45-degree field of view — 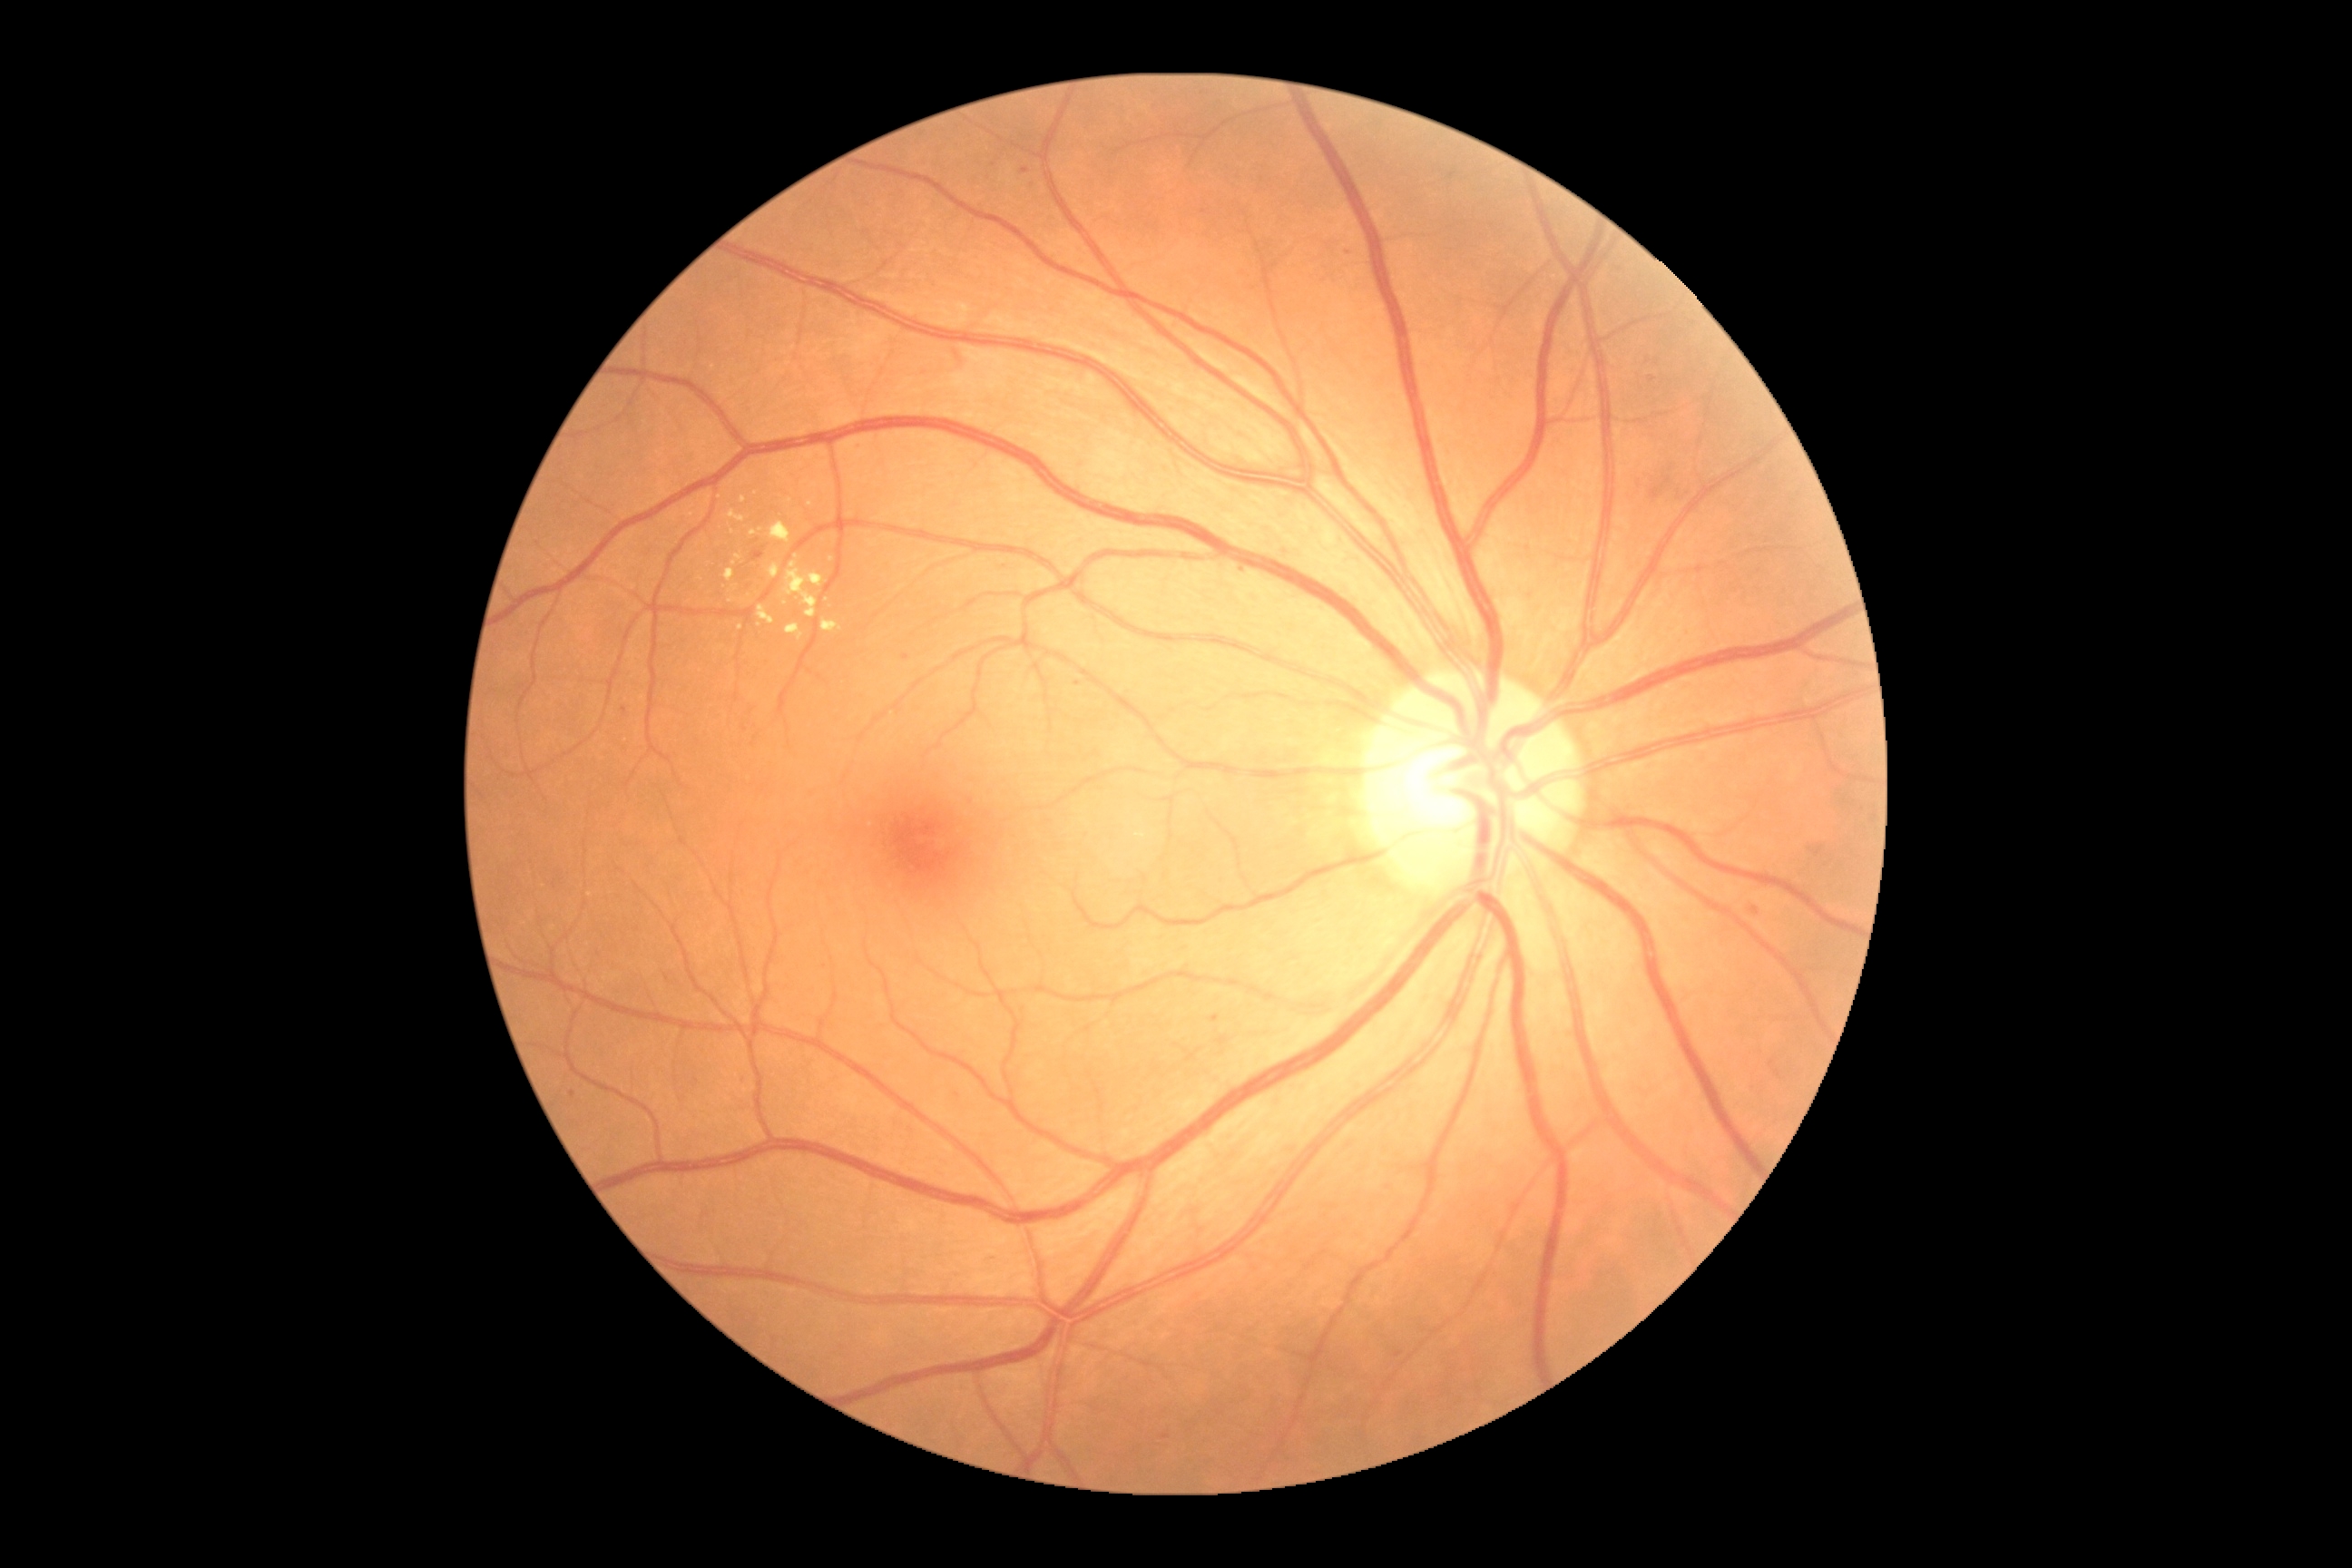

Diabetic retinopathy (DR): 2/4
A subset of detected lesions:
soft exudates (SEs): not present
microaneurysms (MAs) (partial): 1162:1435:1170:1440; 1211:1015:1220:1023; 1396:1351:1404:1358; 1750:908:1759:916; 903:654:910:662
Small MAs near [1388,1187]; [1026,170]; [625,709]; [1078,684]; [1243,571]; [745,1080]; [859,446]; [1350,252]; [959,1096]; [1652,379]; [969,803]; [993,1257]; [573,1095]
hard exudates (EXs) (partial): 785:562:825:618; 750:531:758:536; 758:605:776:625; 821:620:843:632; 729:511:745:524
Small EXs near [733,532]; [787,604]; [732,600]; [740,628]; [714,565]; [759,625]; [590,894]; [834,536]
hemorrhages (HEs): not present